Non-mydriatic acquisition — 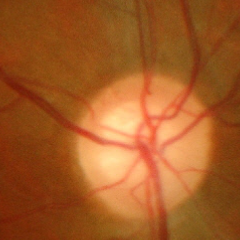

Optic nerve head appearance consistent with severe glaucomatous damage.